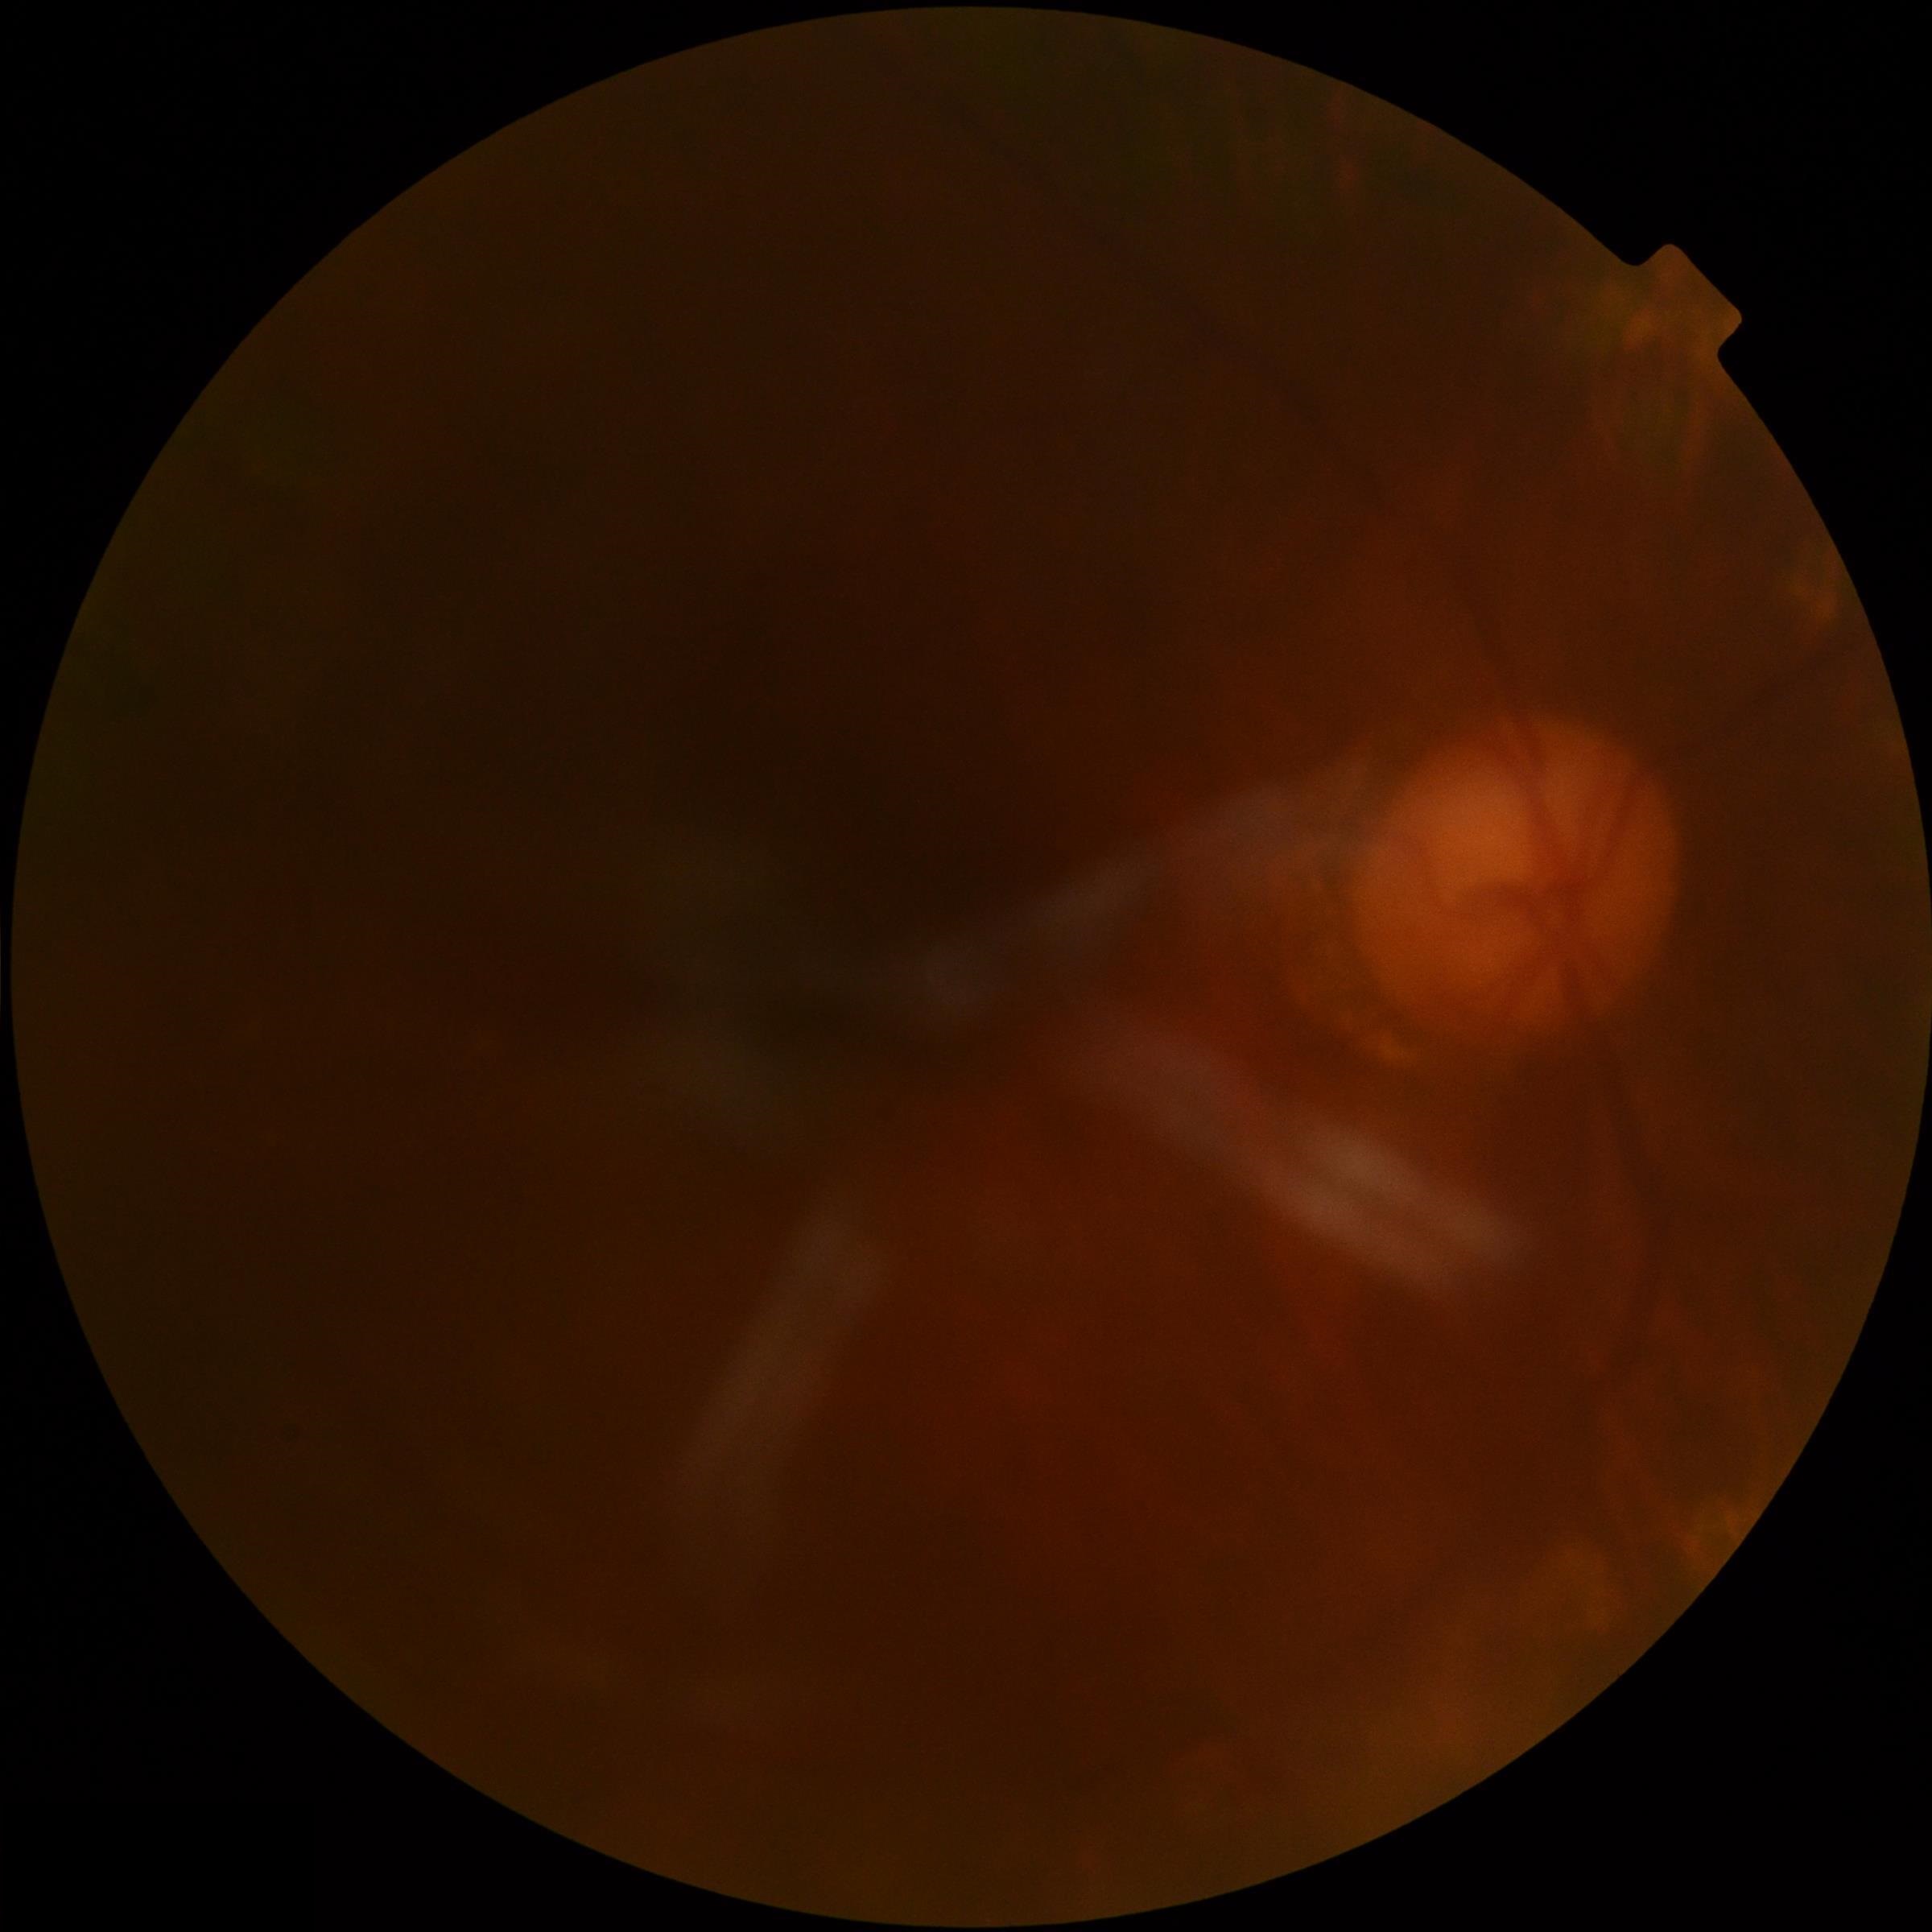
{
  "quality": "too poor for DR grading",
  "dr_grade": "ungradable due to poor image quality"
}